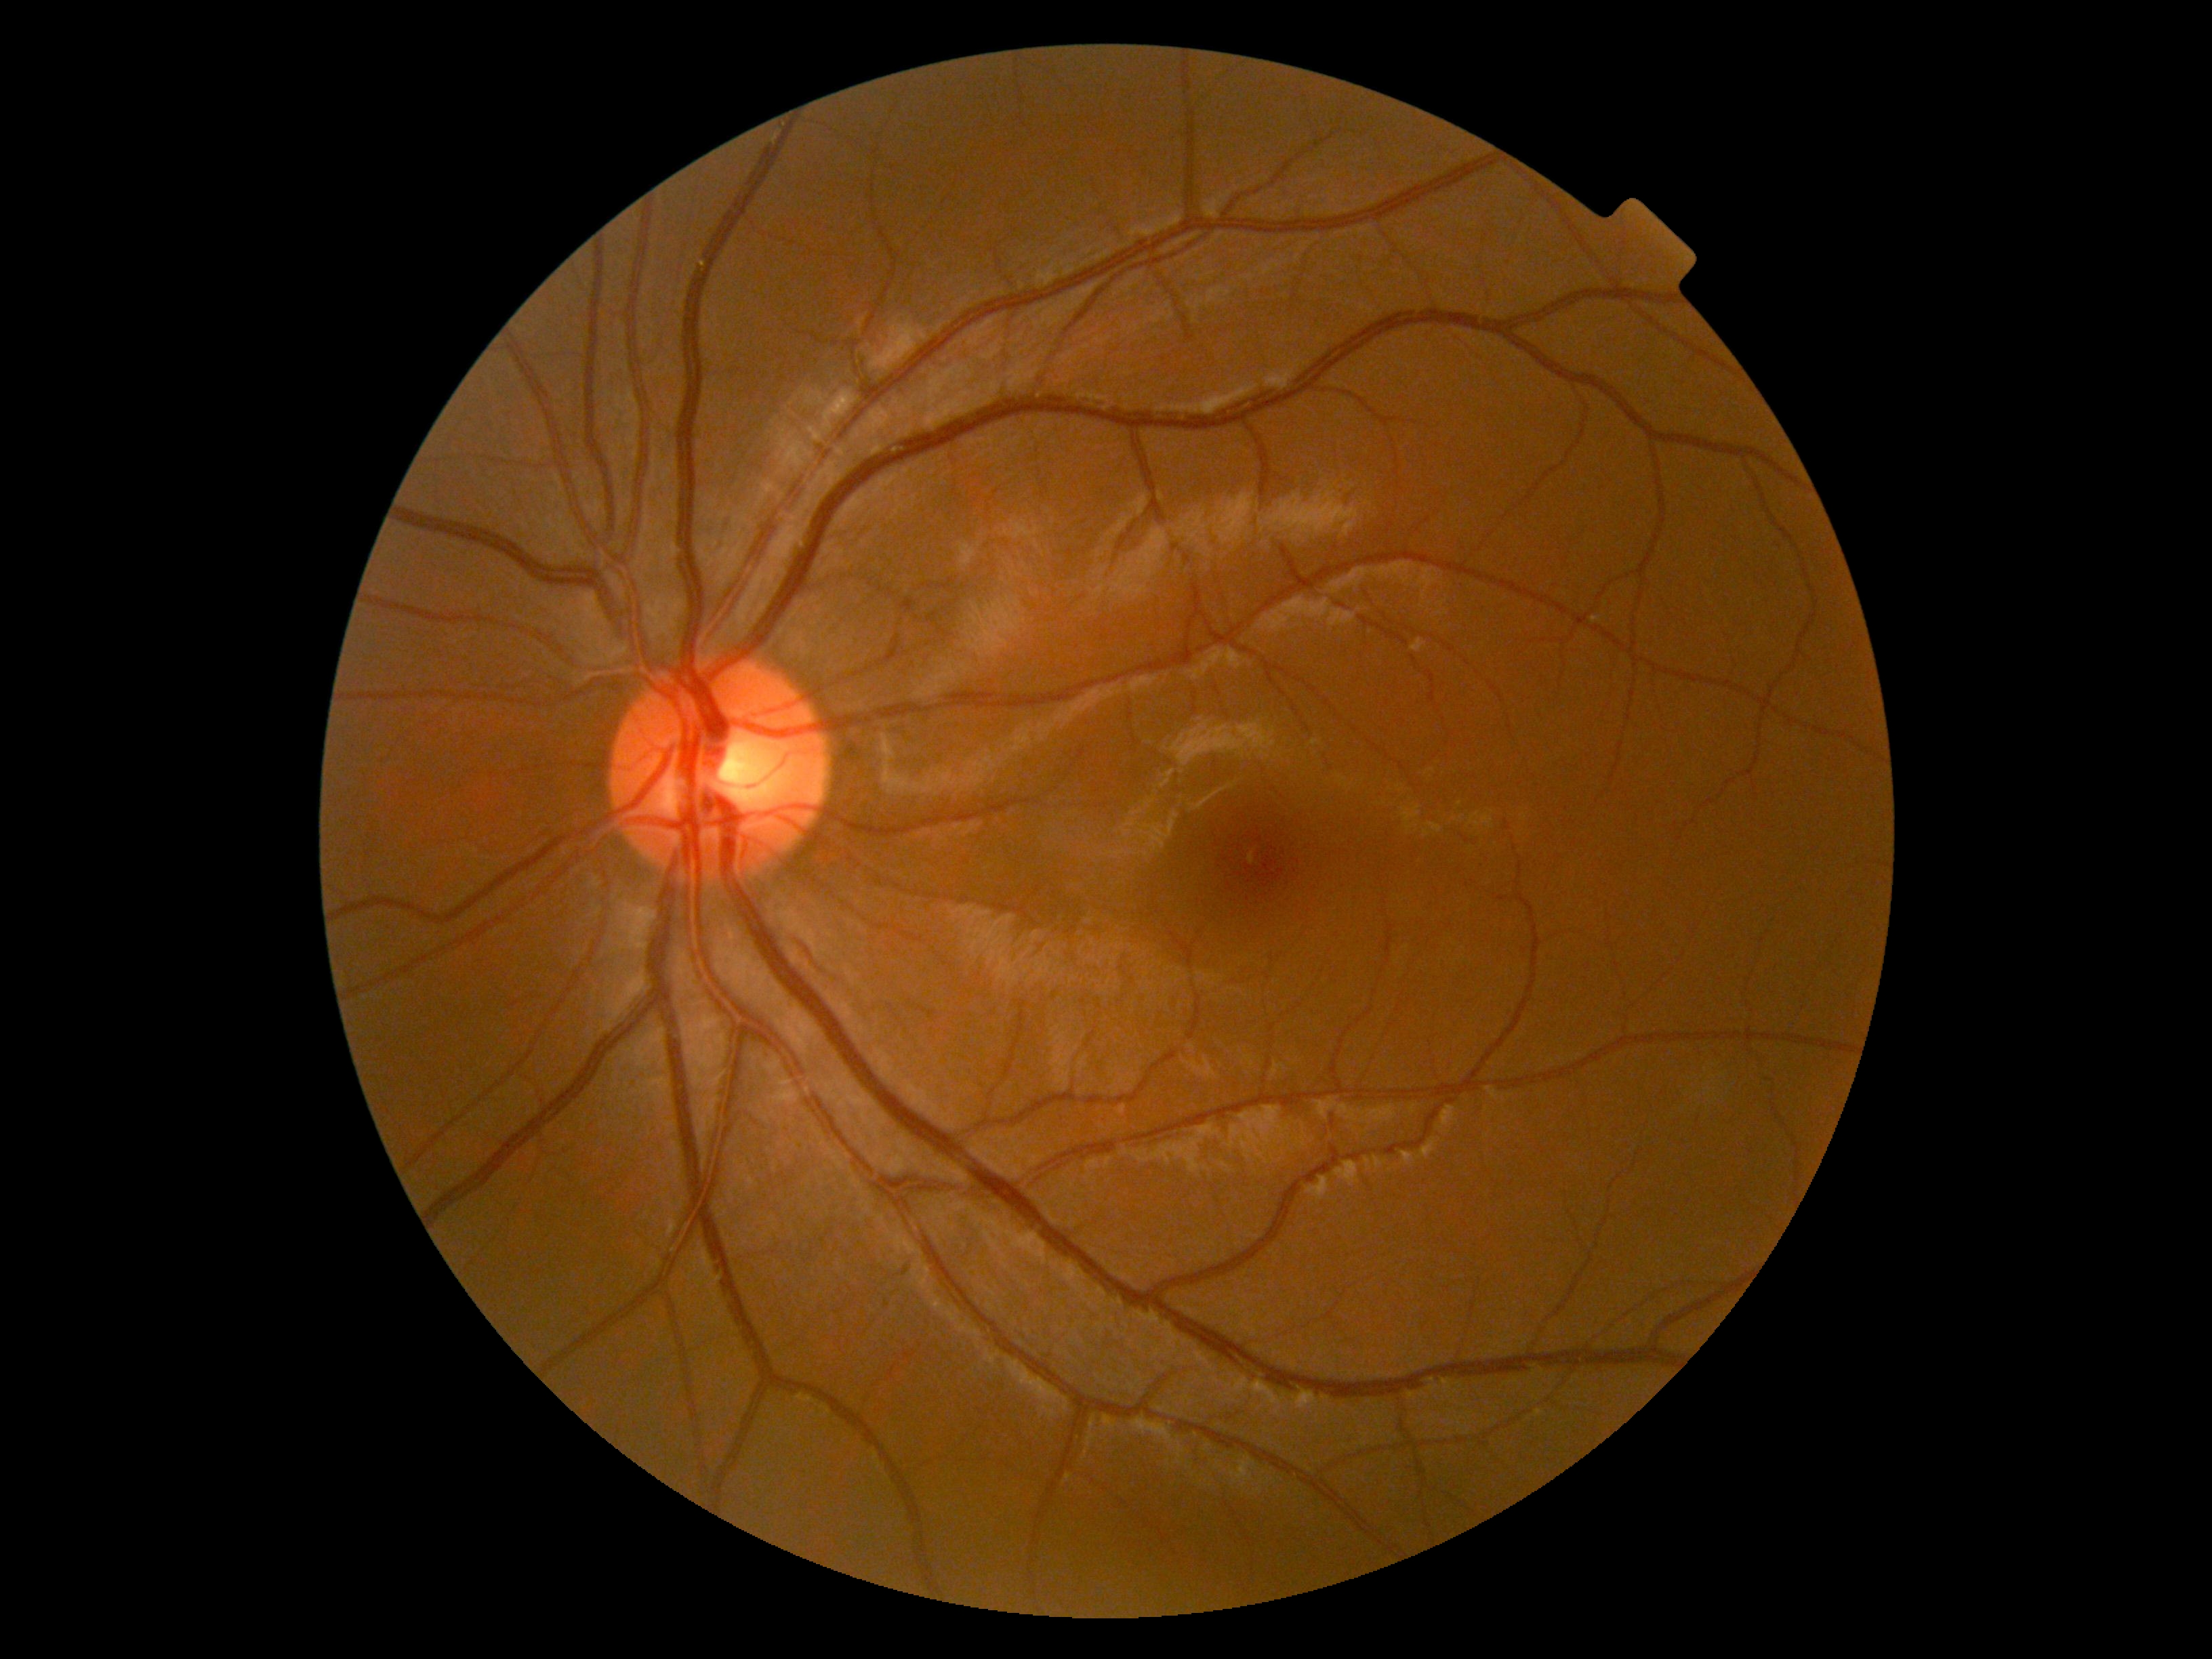
retinopathy: grade 0 (no apparent retinopathy).